2352 x 1568 pixels.
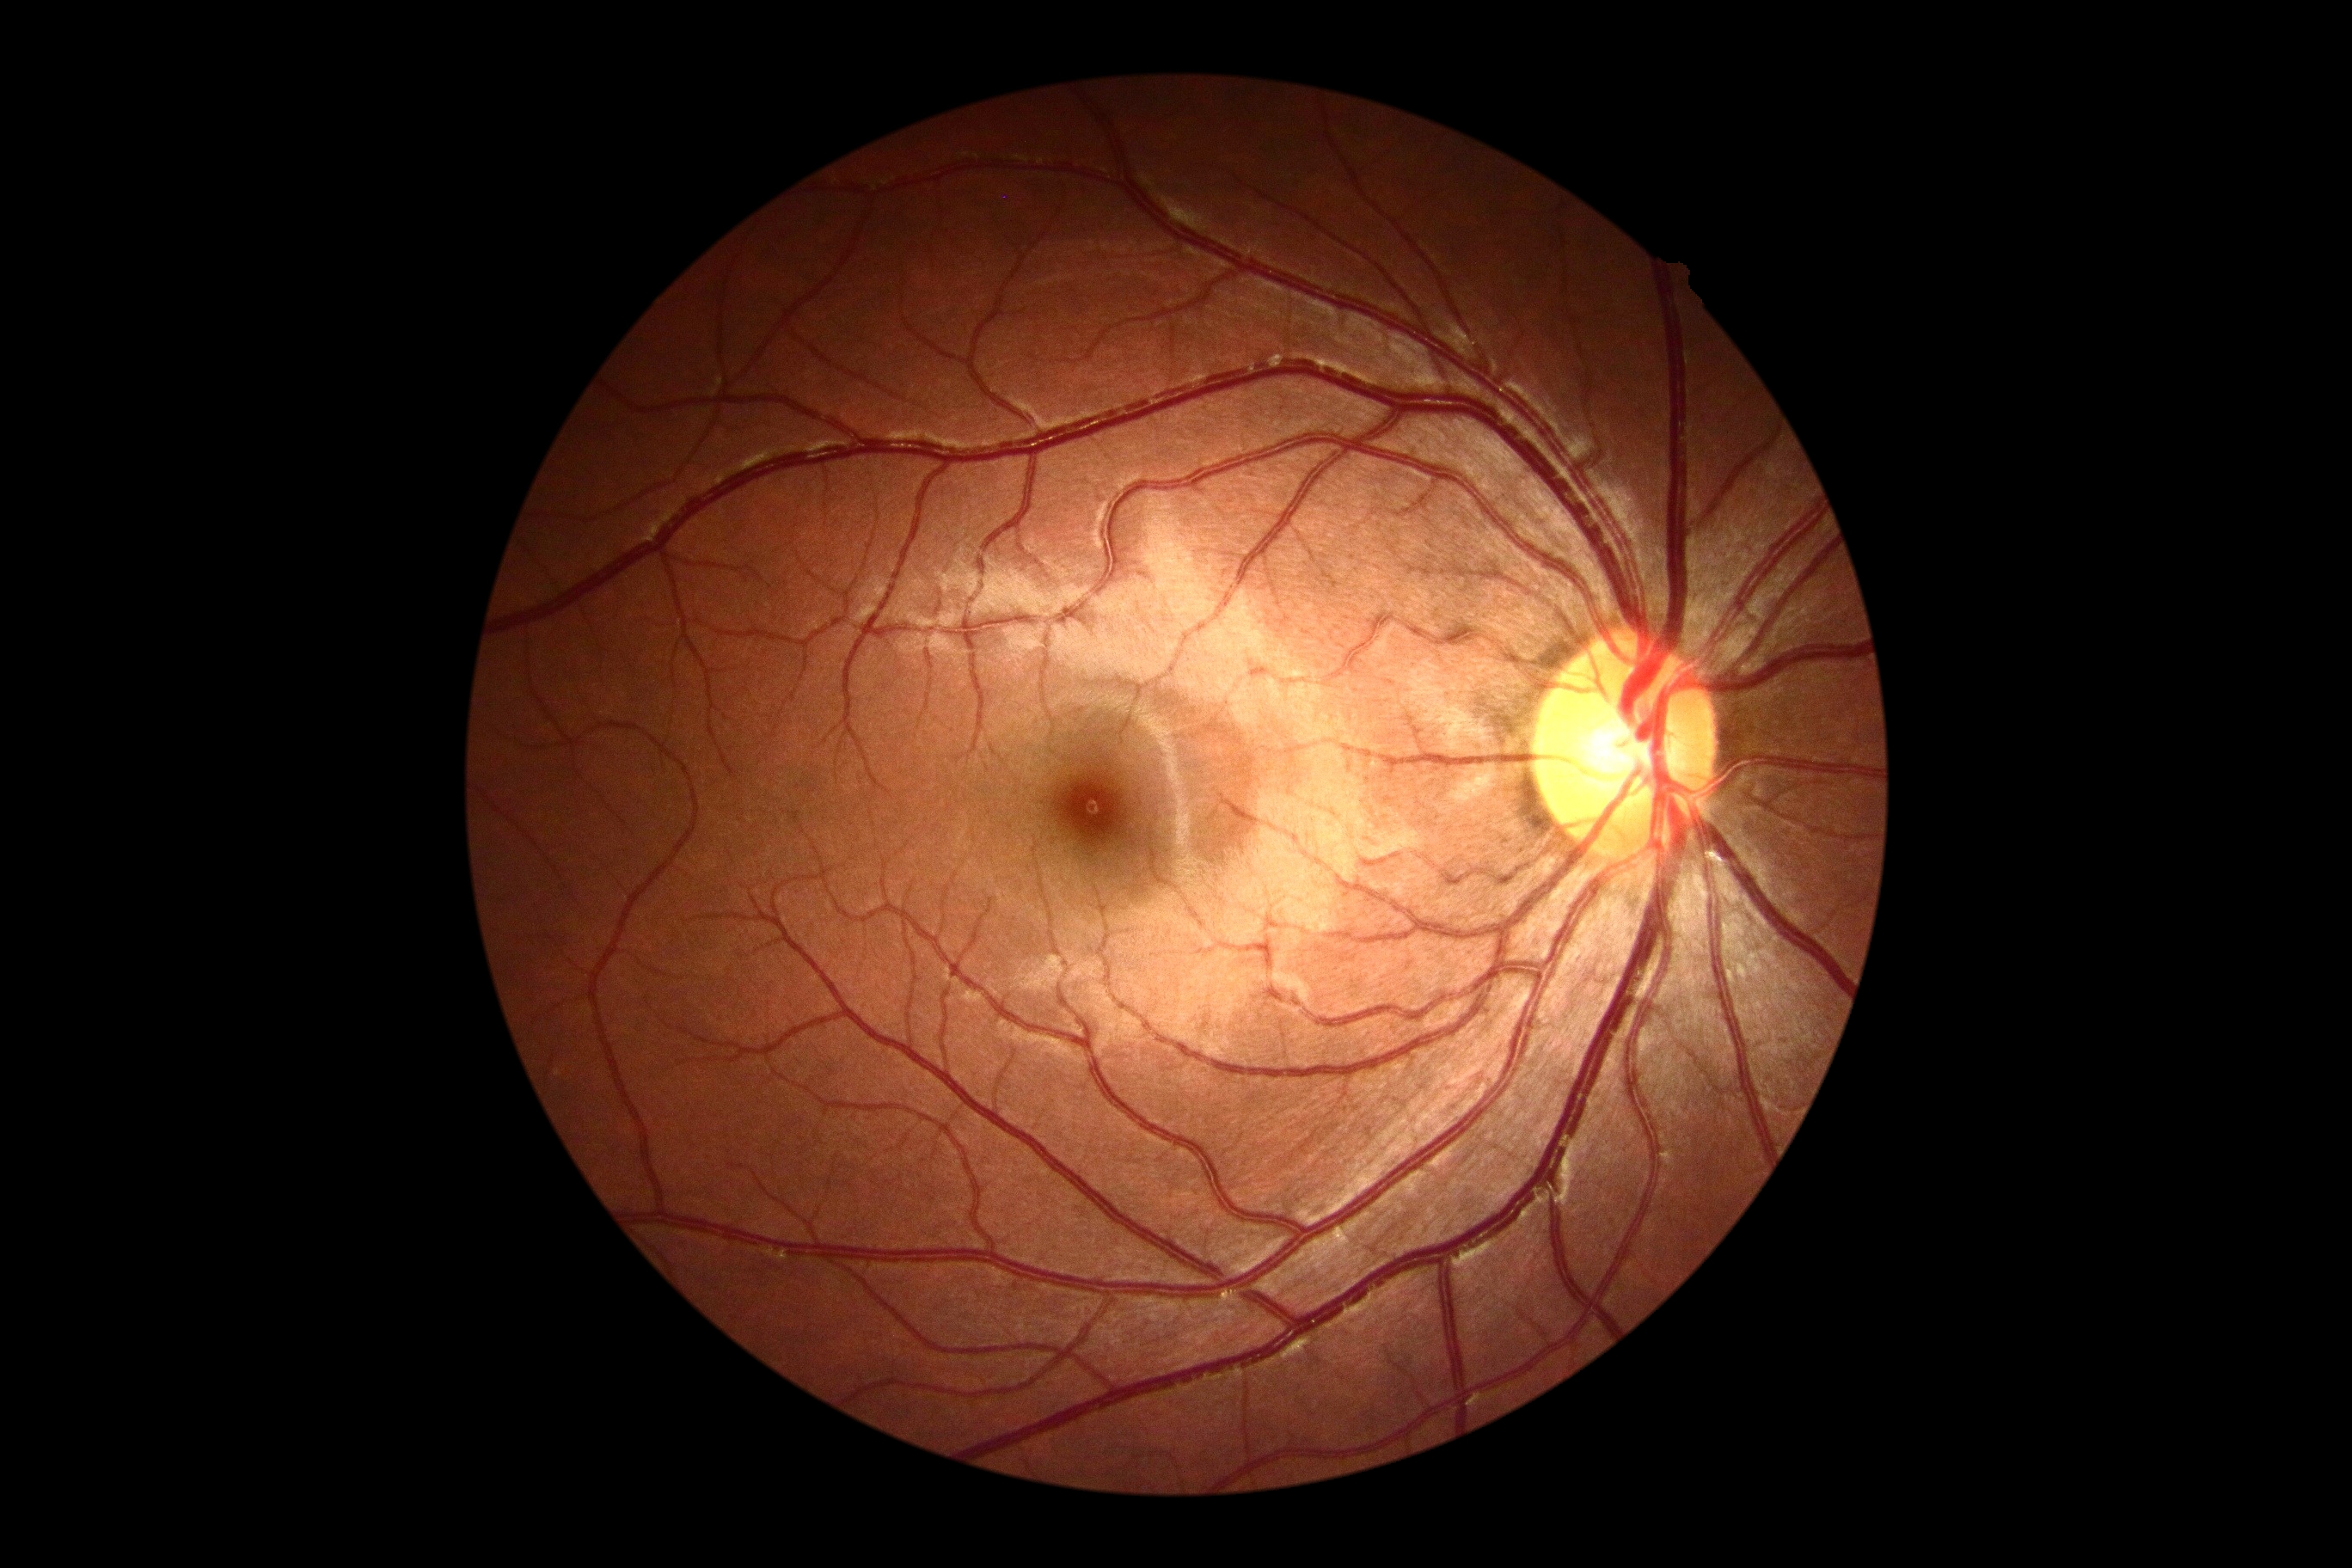
{
  "dr_grade": "0 — no visible signs of diabetic retinopathy",
  "dr_impression": "no signs of DR"
}